Color fundus photograph, FOV: 45 degrees:
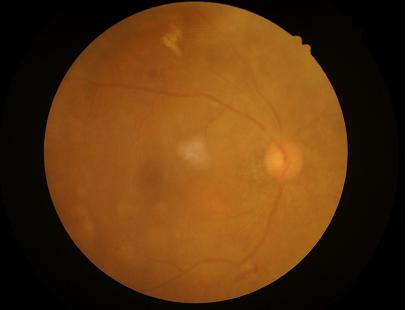

No over- or under-exposure.
Noticeable blur in the optic disc, vessels, or background.
Contrast is low.
Overall quality is poor; the image is difficult to grade.